Camera: Phoenix ICON (100° FOV); Phoenix ICON wide-field infant fundus image:
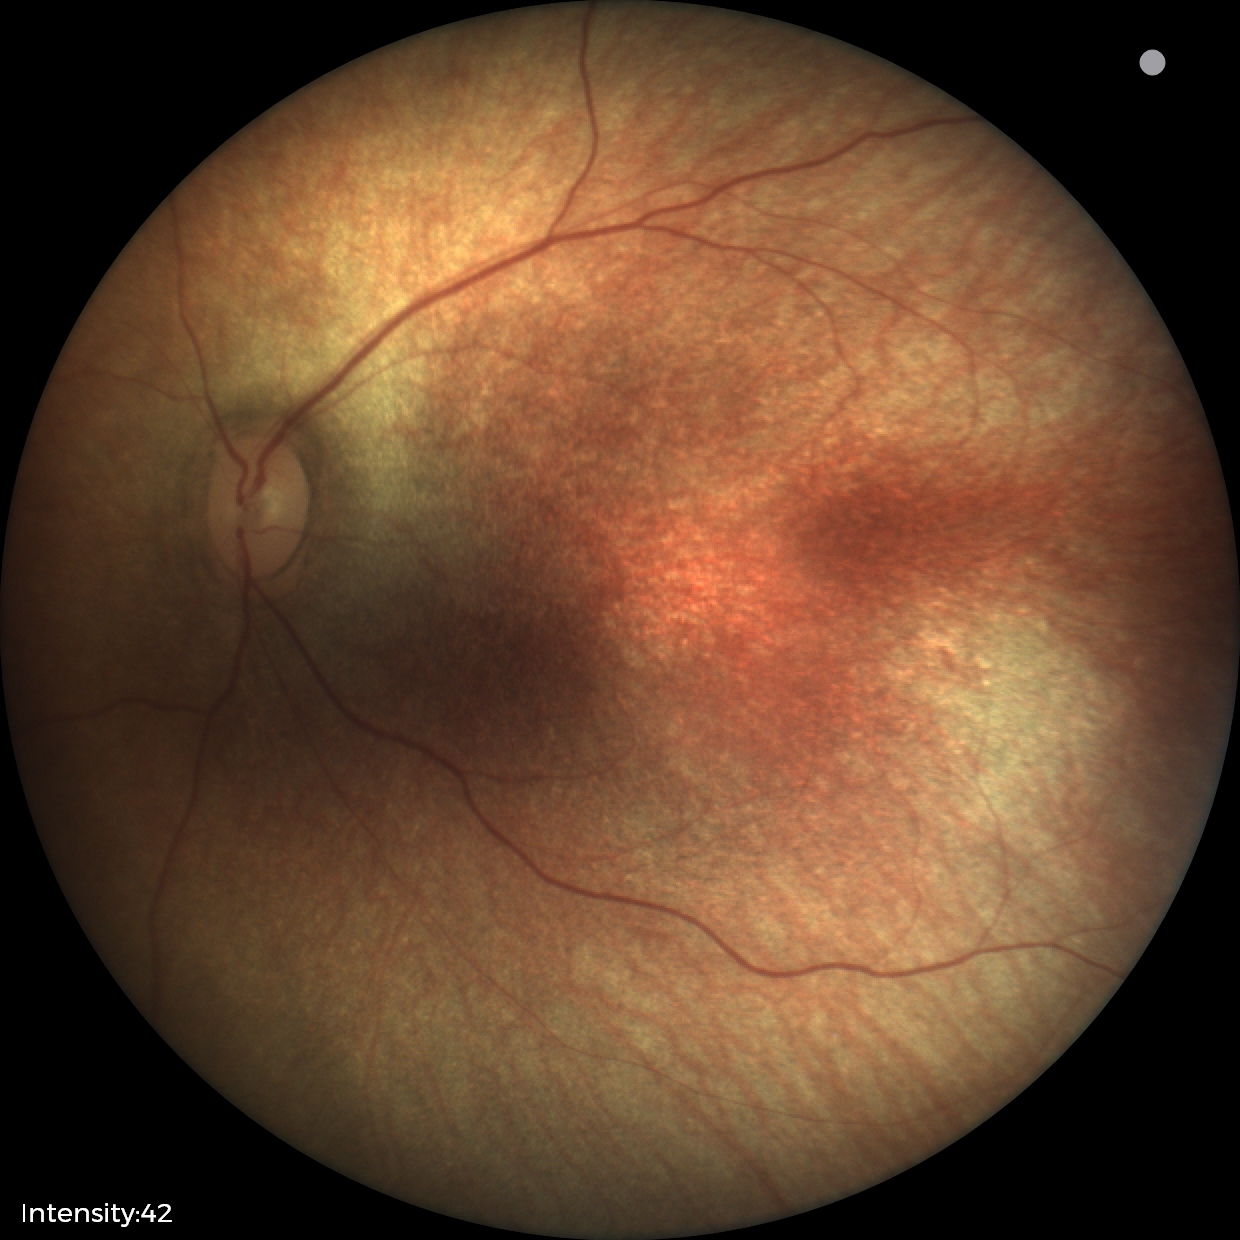
Screening: no abnormal retinal findings.